Infant wide-field fundus photograph; captured with the Clarity RetCam 3 (130° field of view): 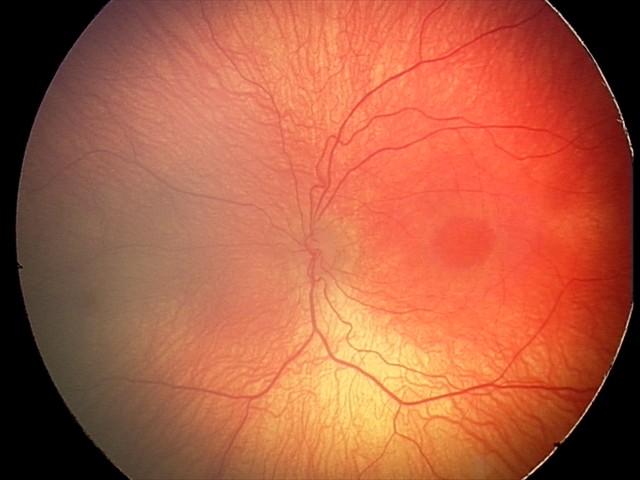
Diagnosis from this screening exam: retinopathy of prematurity stage 2. Without plus disease.